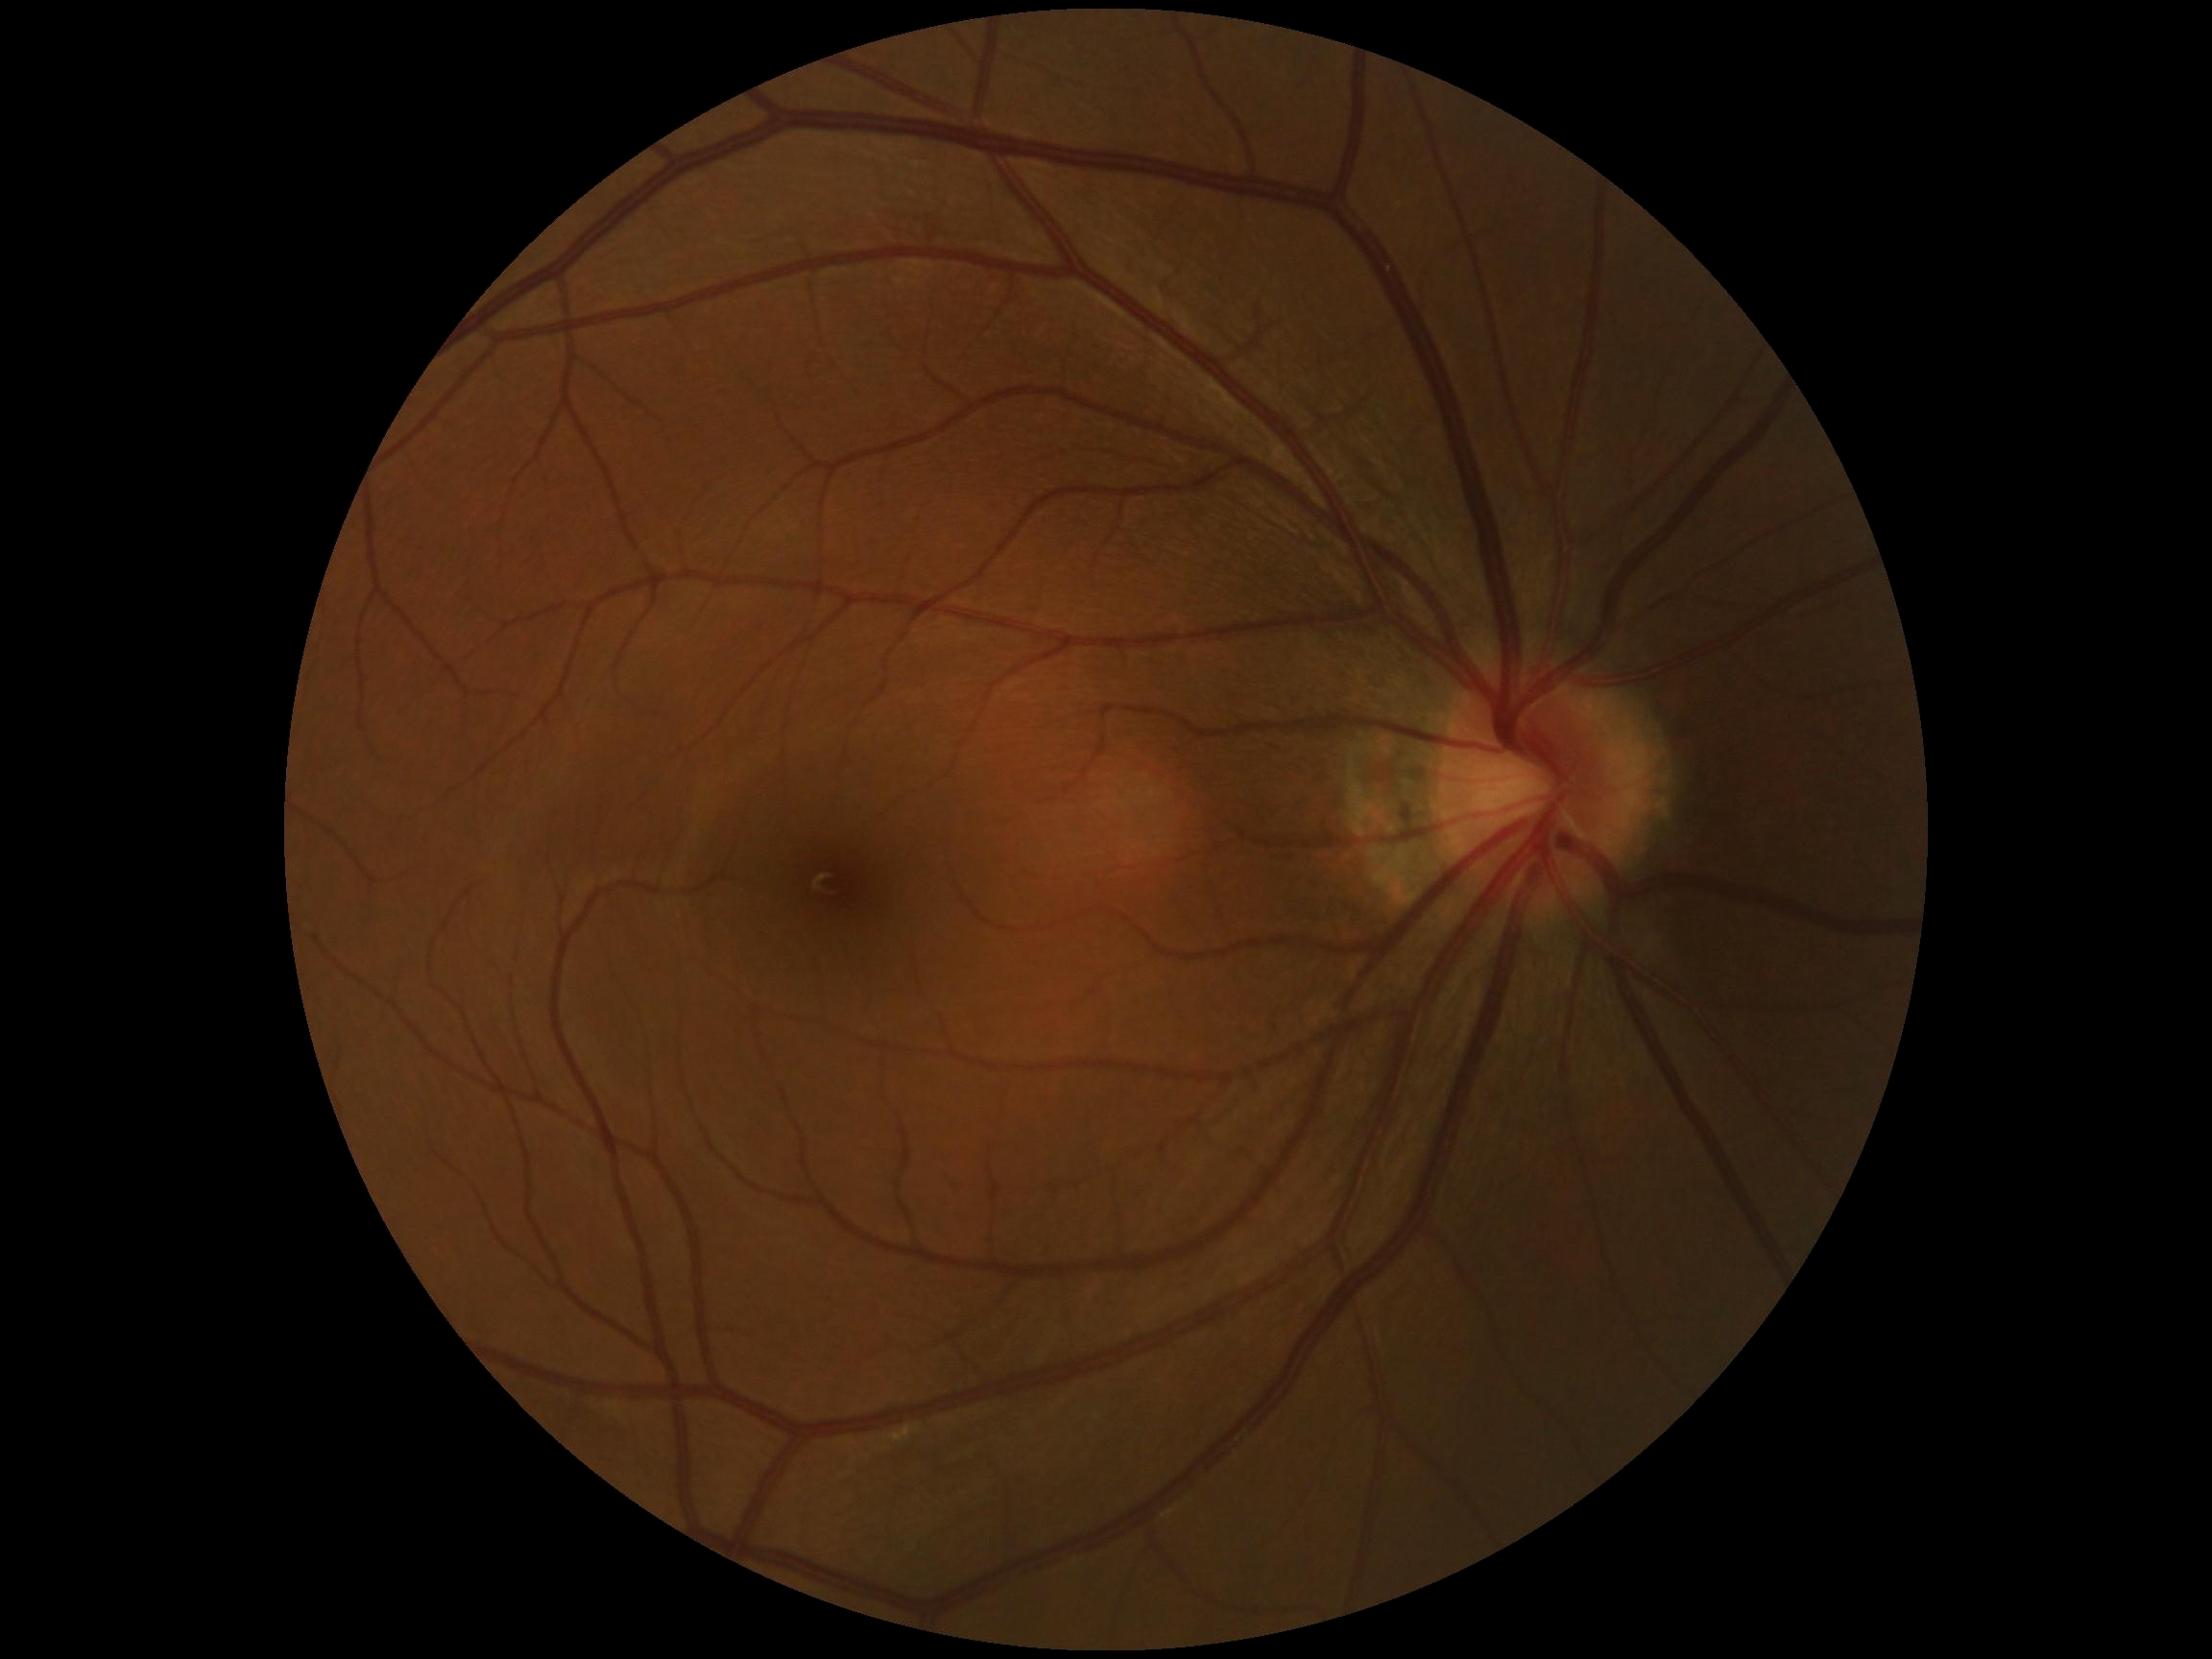 {
  "dr_grade": "no apparent diabetic retinopathy (grade 0) — no visible signs of diabetic retinopathy"
}